45° FOV · posterior pole color fundus photograph — 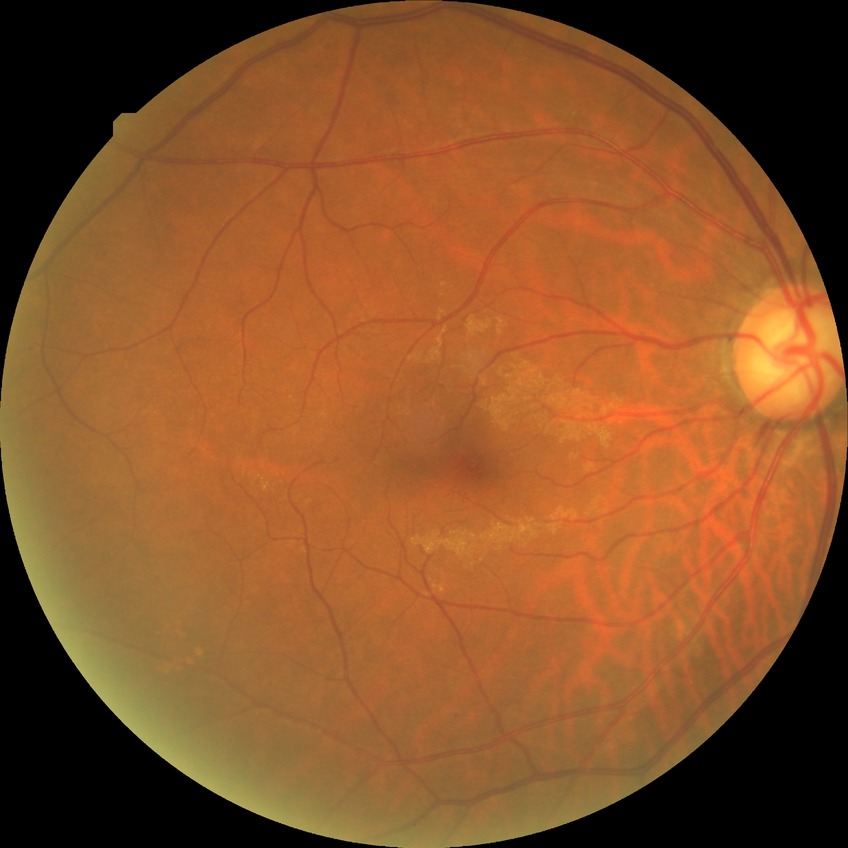
Diabetic retinopathy (DR): no diabetic retinopathy (NDR).